Diabetic retinopathy graded by the modified Davis classification, fundus photo, NIDEK AFC-230:
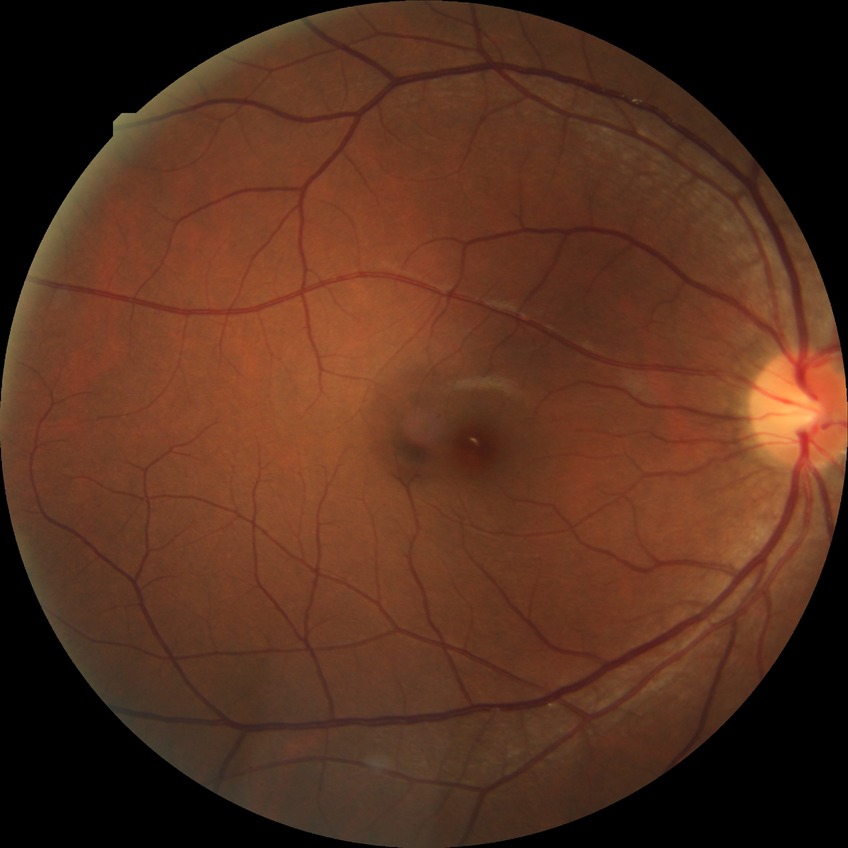 DR impression: no apparent DR; DR: NDR.